Wide-field retinal mosaic image: 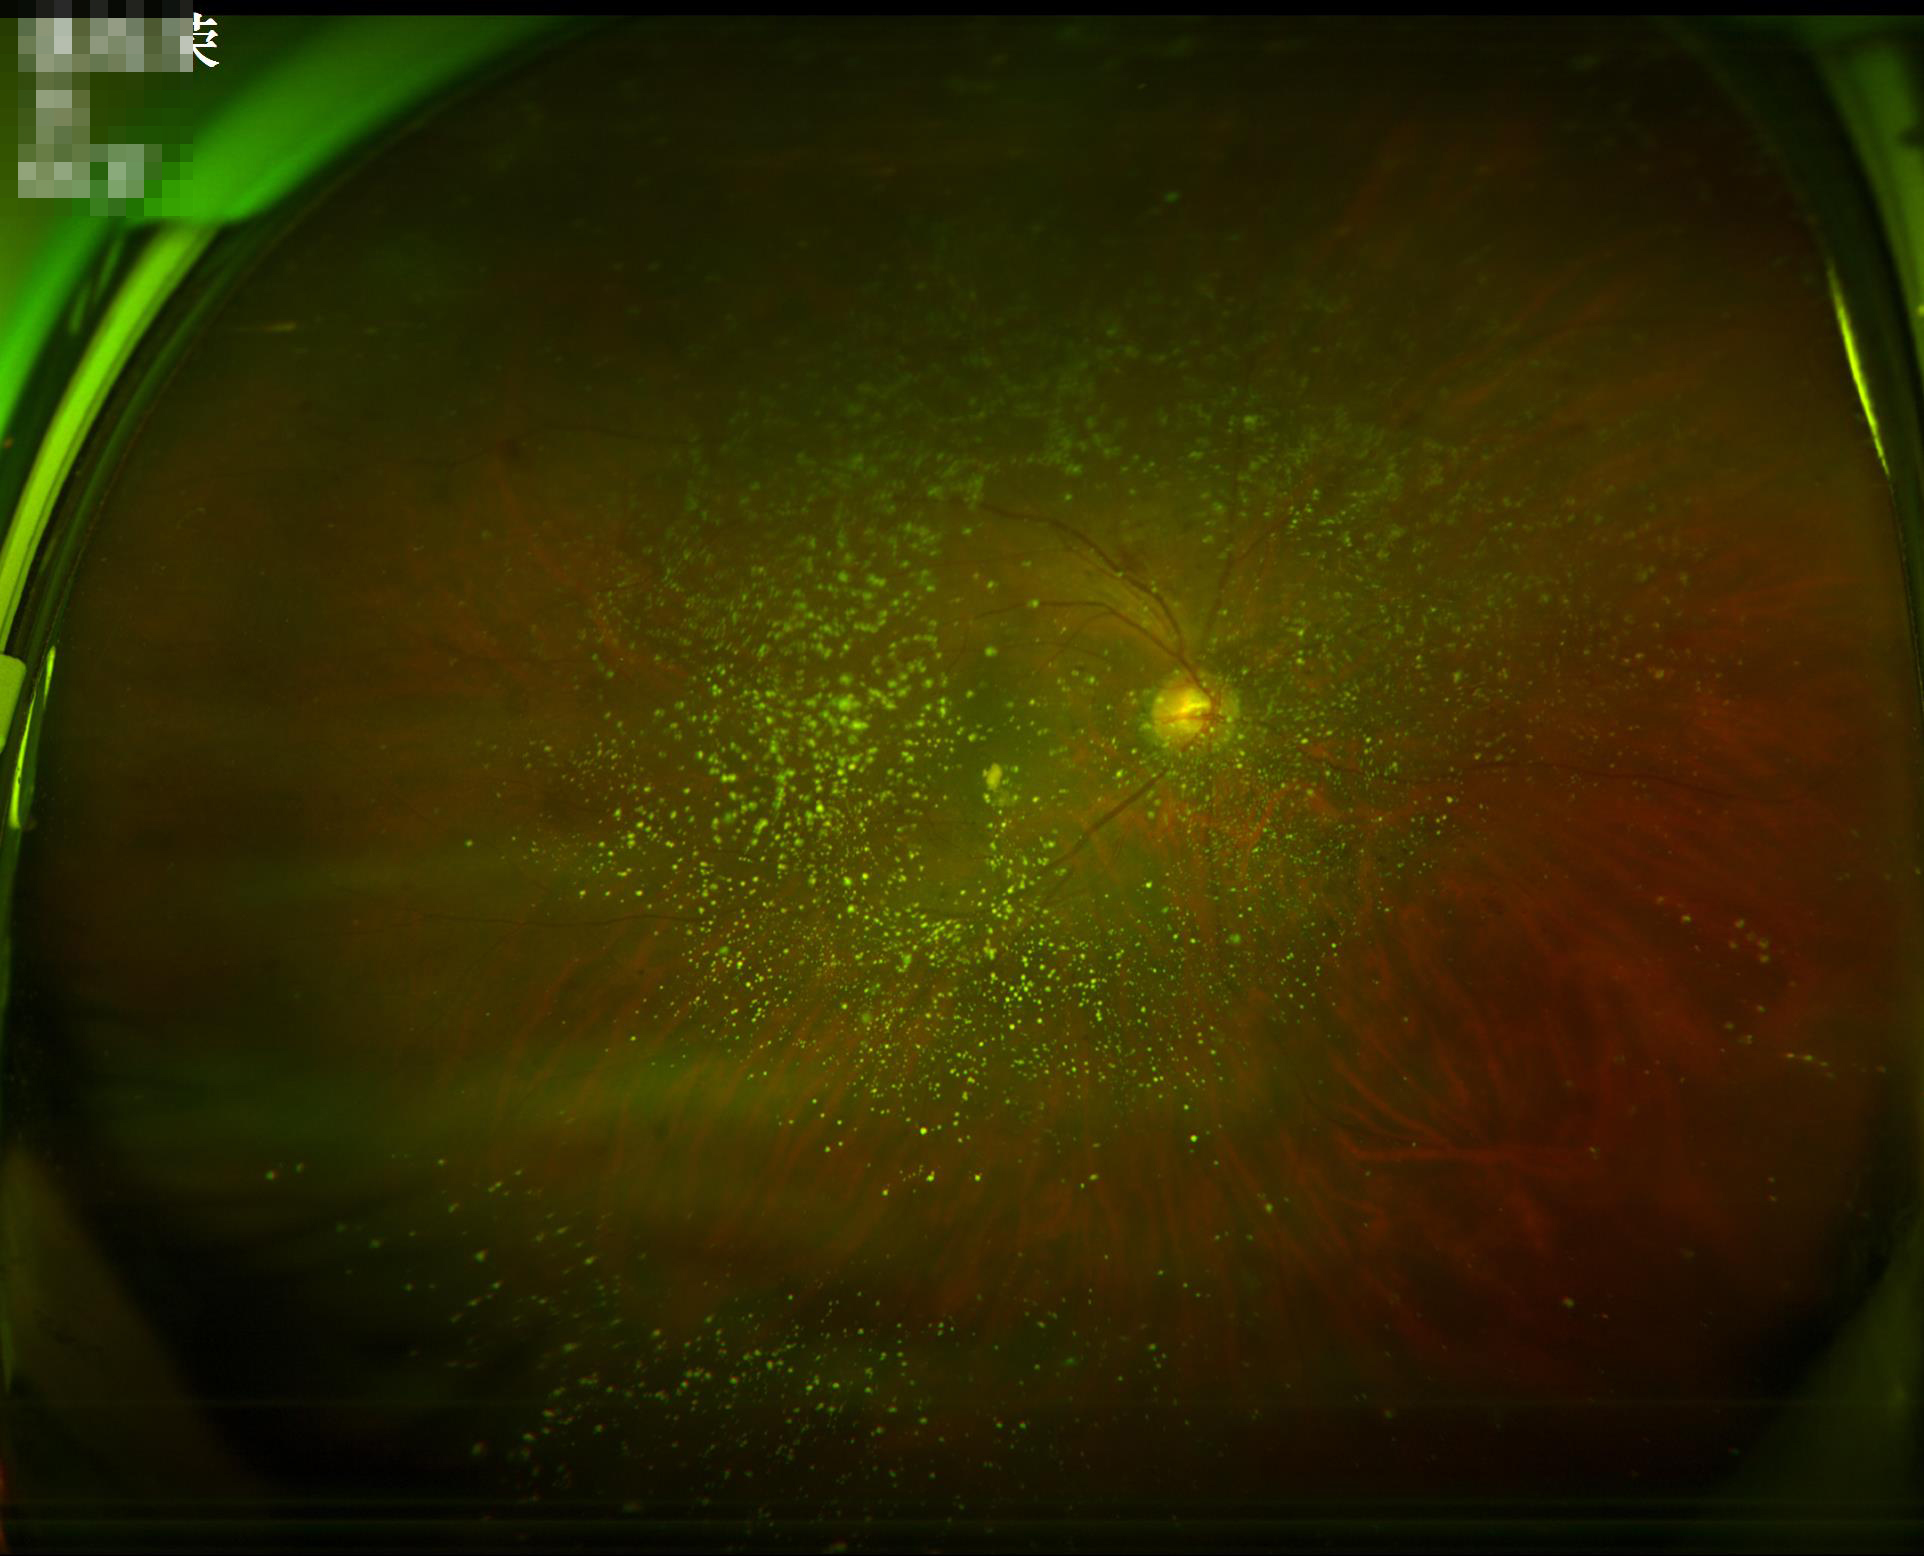
Image quality: illumination: over- or under-exposed; overall: inadequate for clinical interpretation; contrast: vessels and details readily distinguishable; clarity: noticeable blur in the optic disc, vessels, or background.